45-degree field of view: 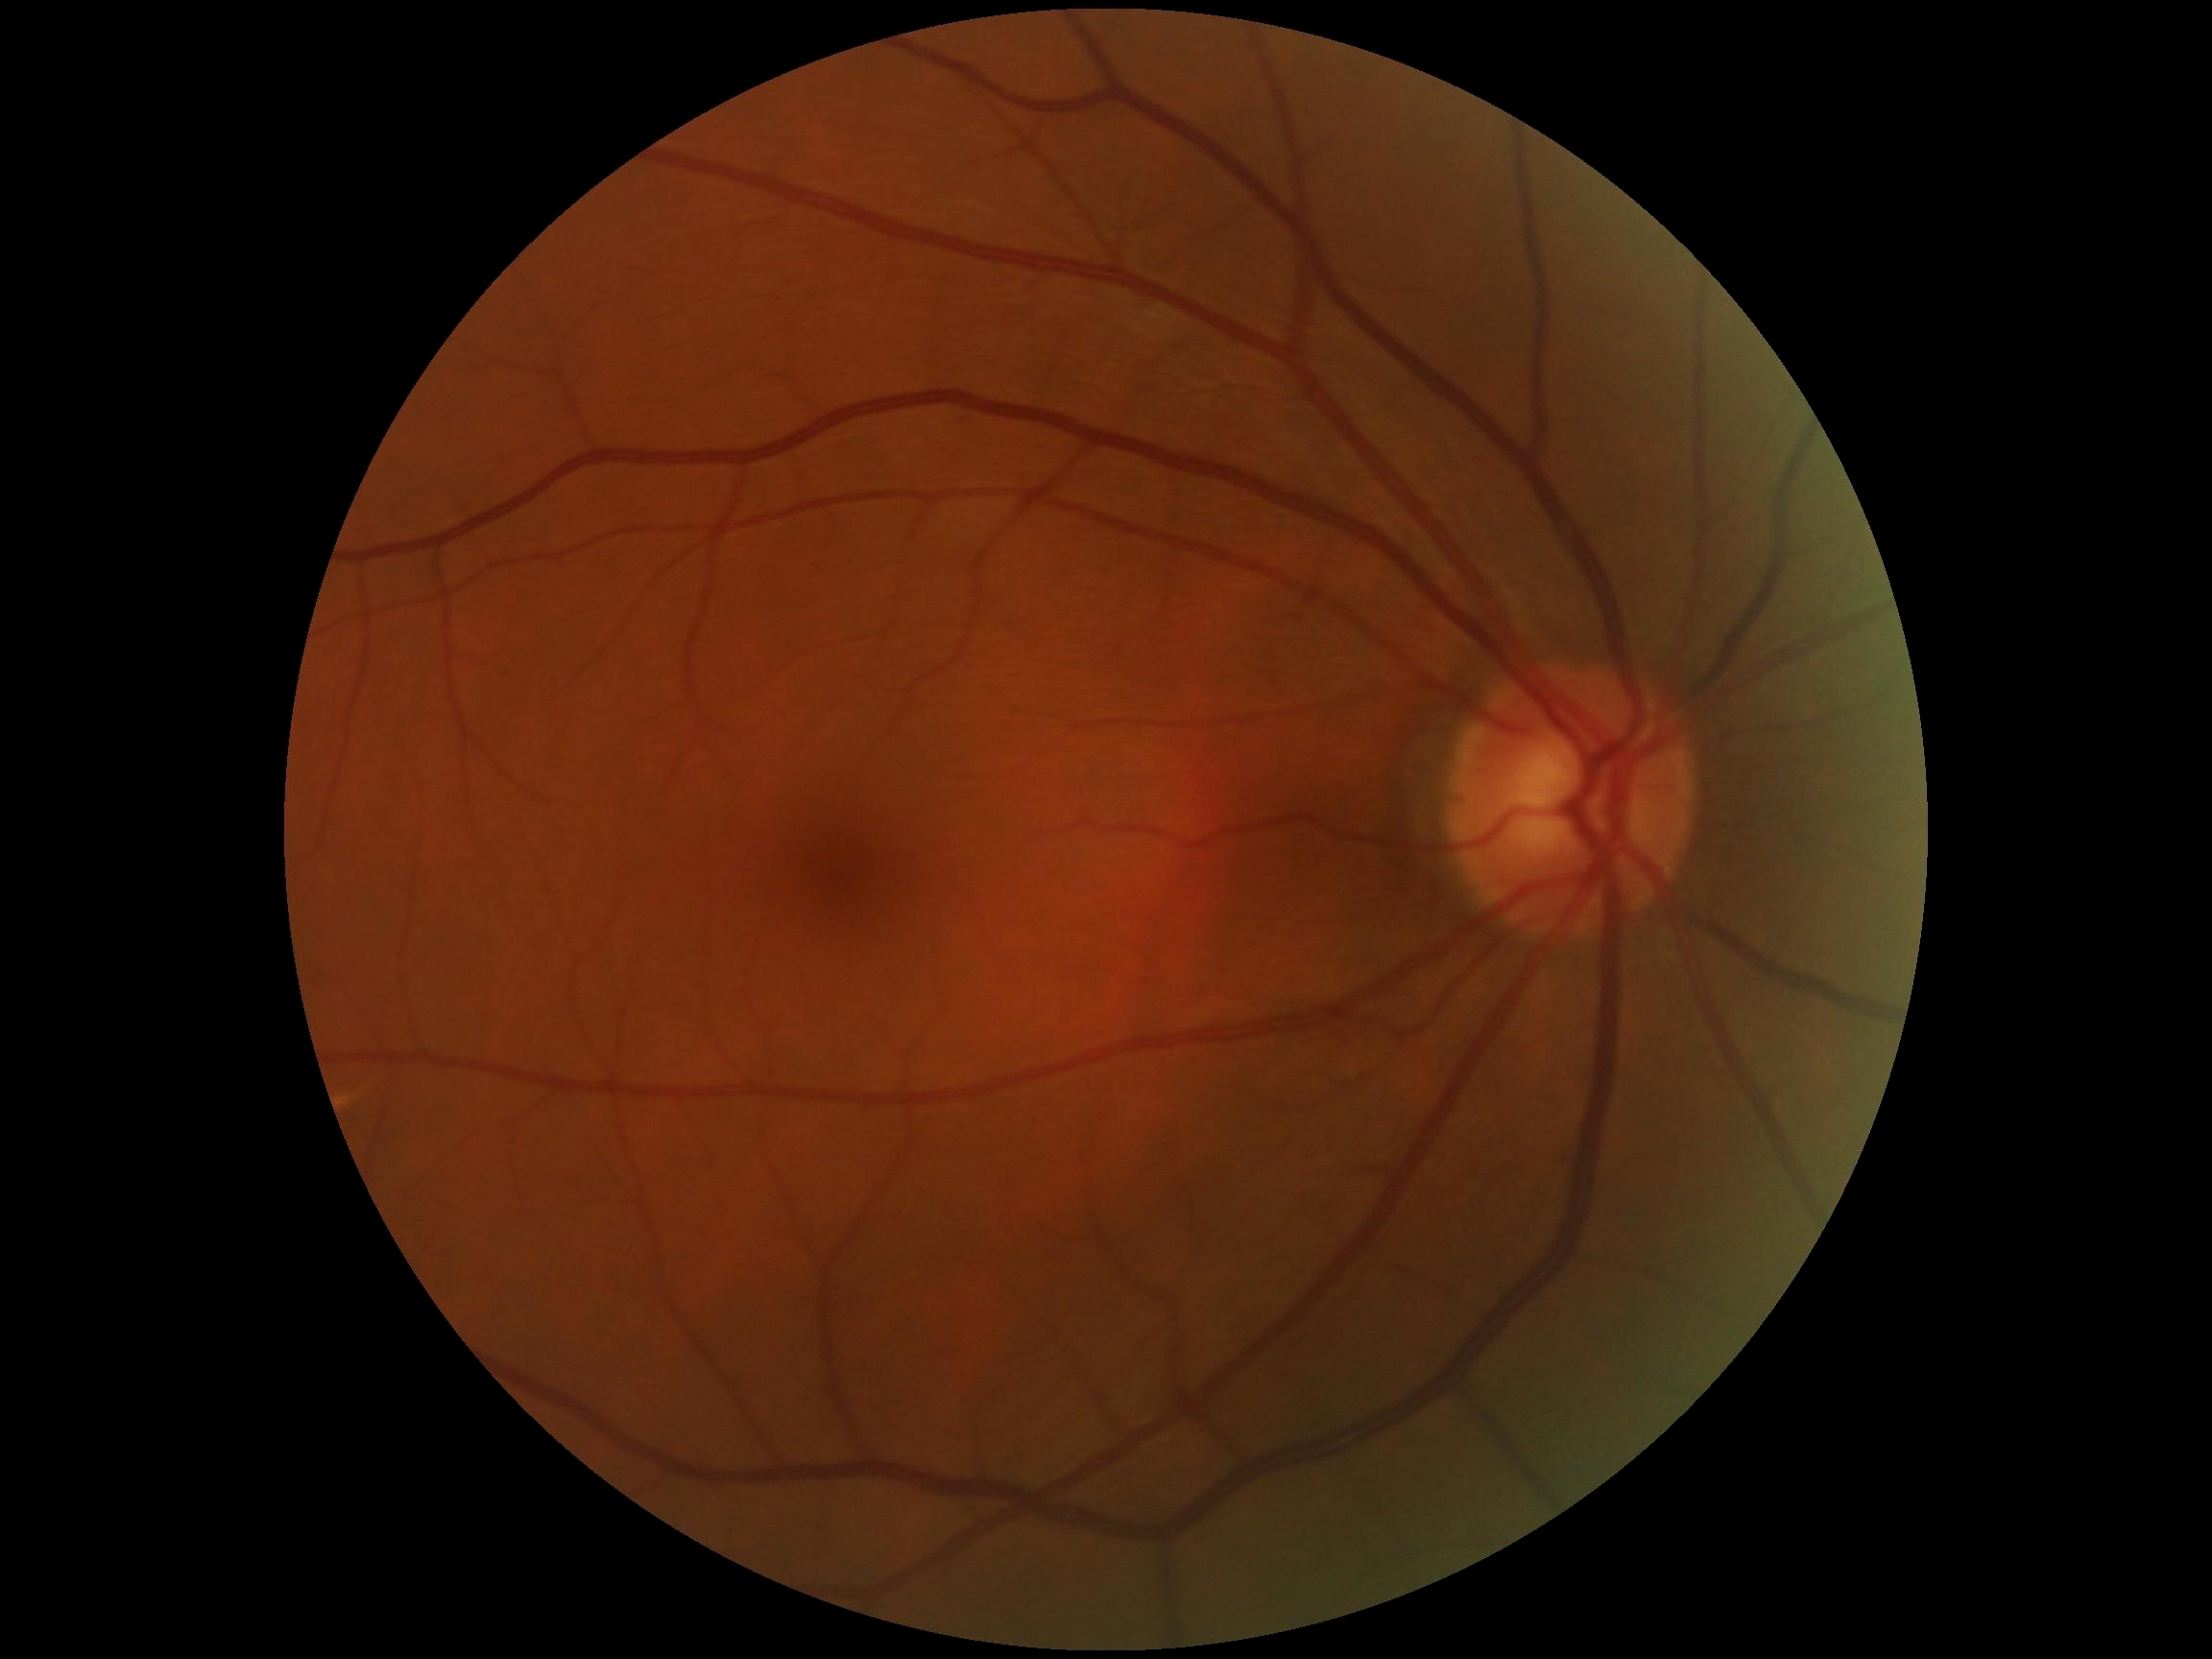

Diabetic retinopathy severity: grade 0 (no apparent retinopathy).